Fundus photo.
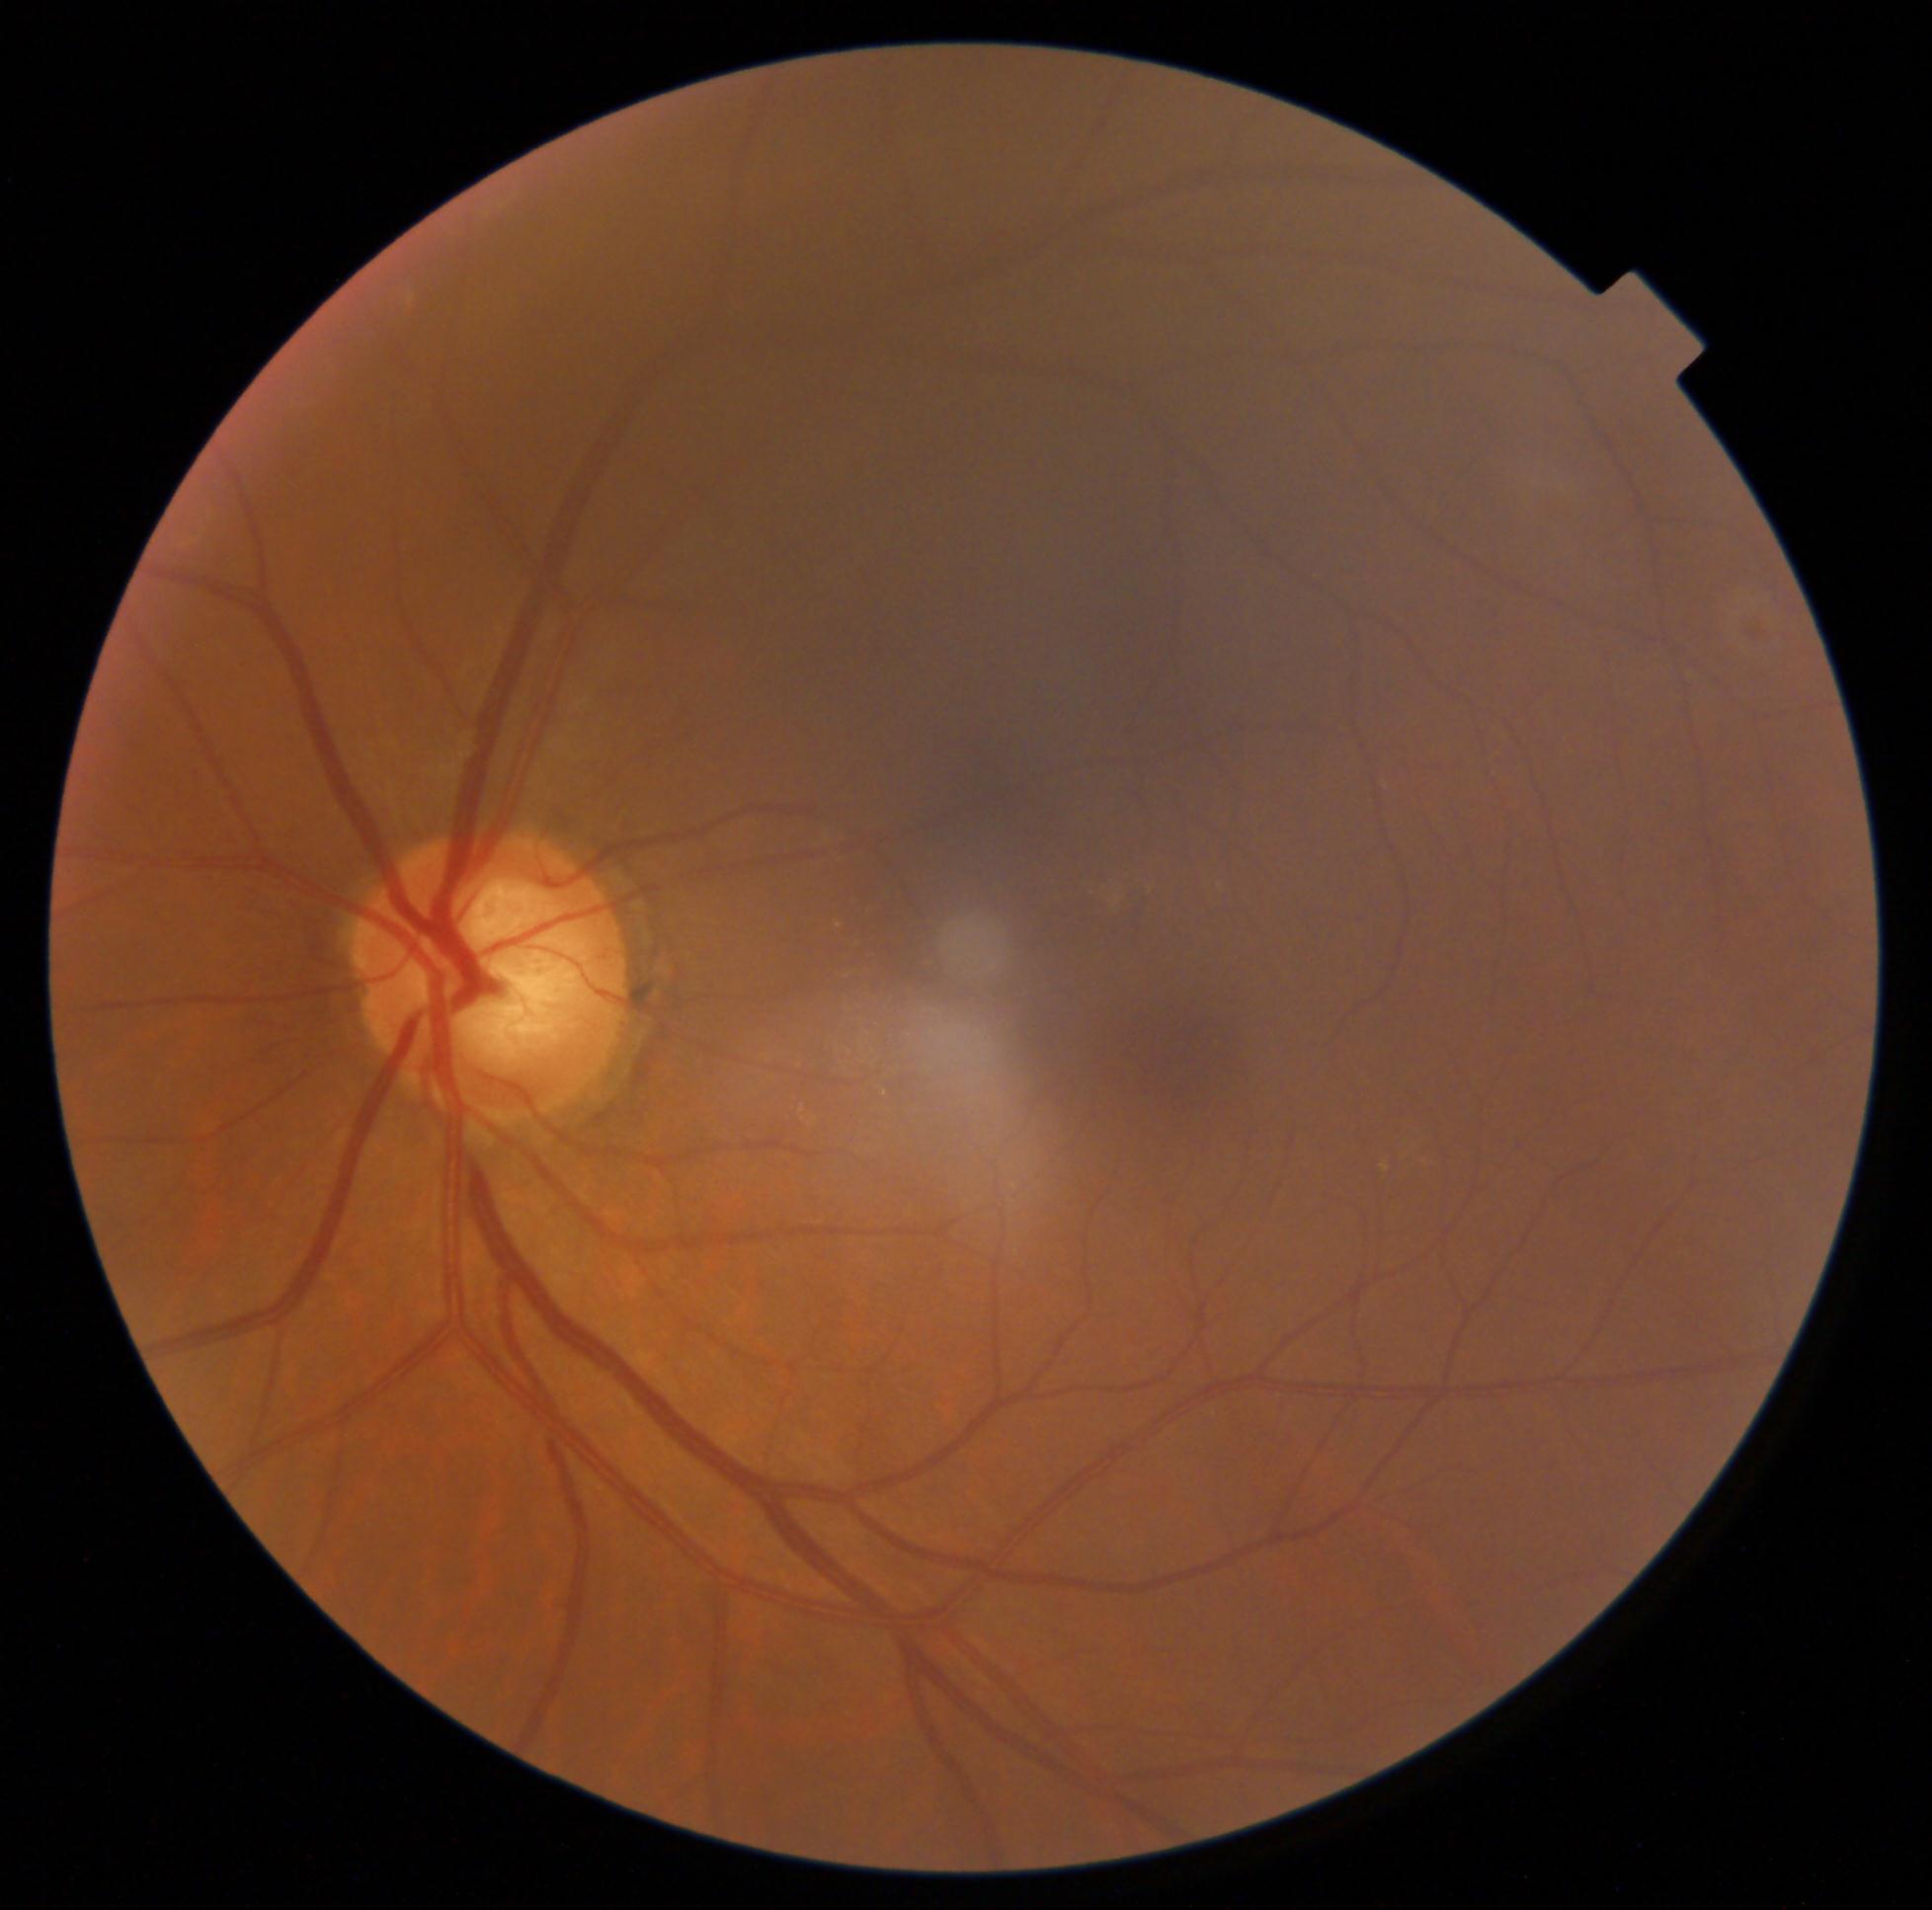

No diabetic retinal disease findings.
Retinopathy grade is no apparent retinopathy (0).